2048x1536px. Fundus photo: 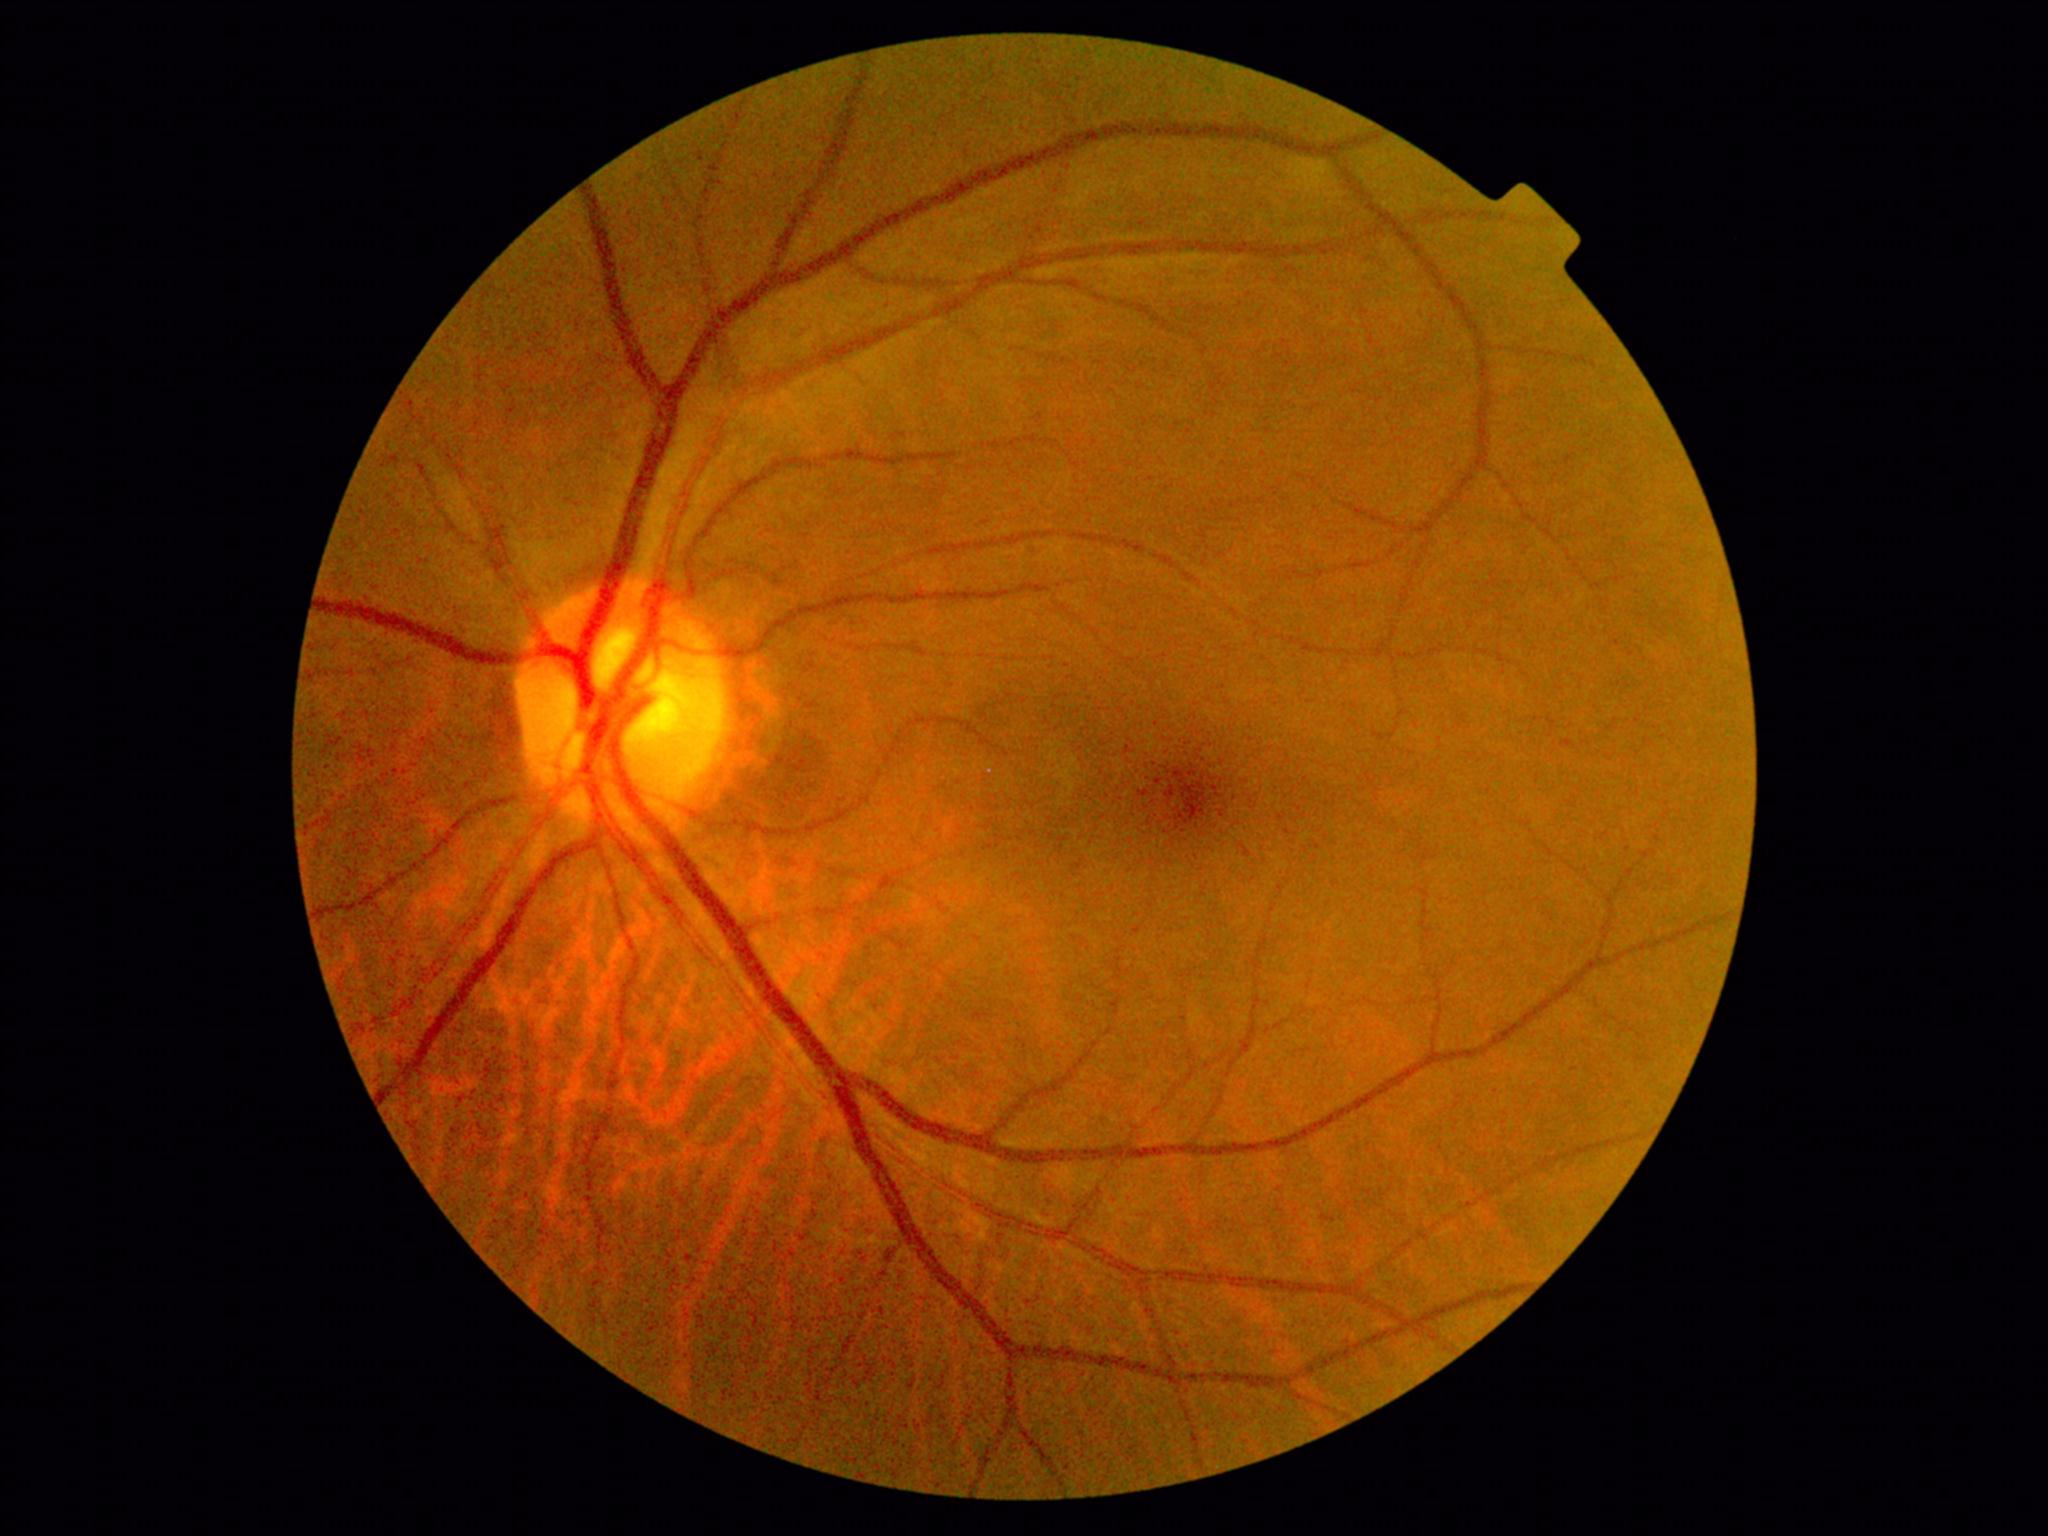
Retinopathy grade is no apparent retinopathy (0). No DR findings.